2212 by 1659 pixels: 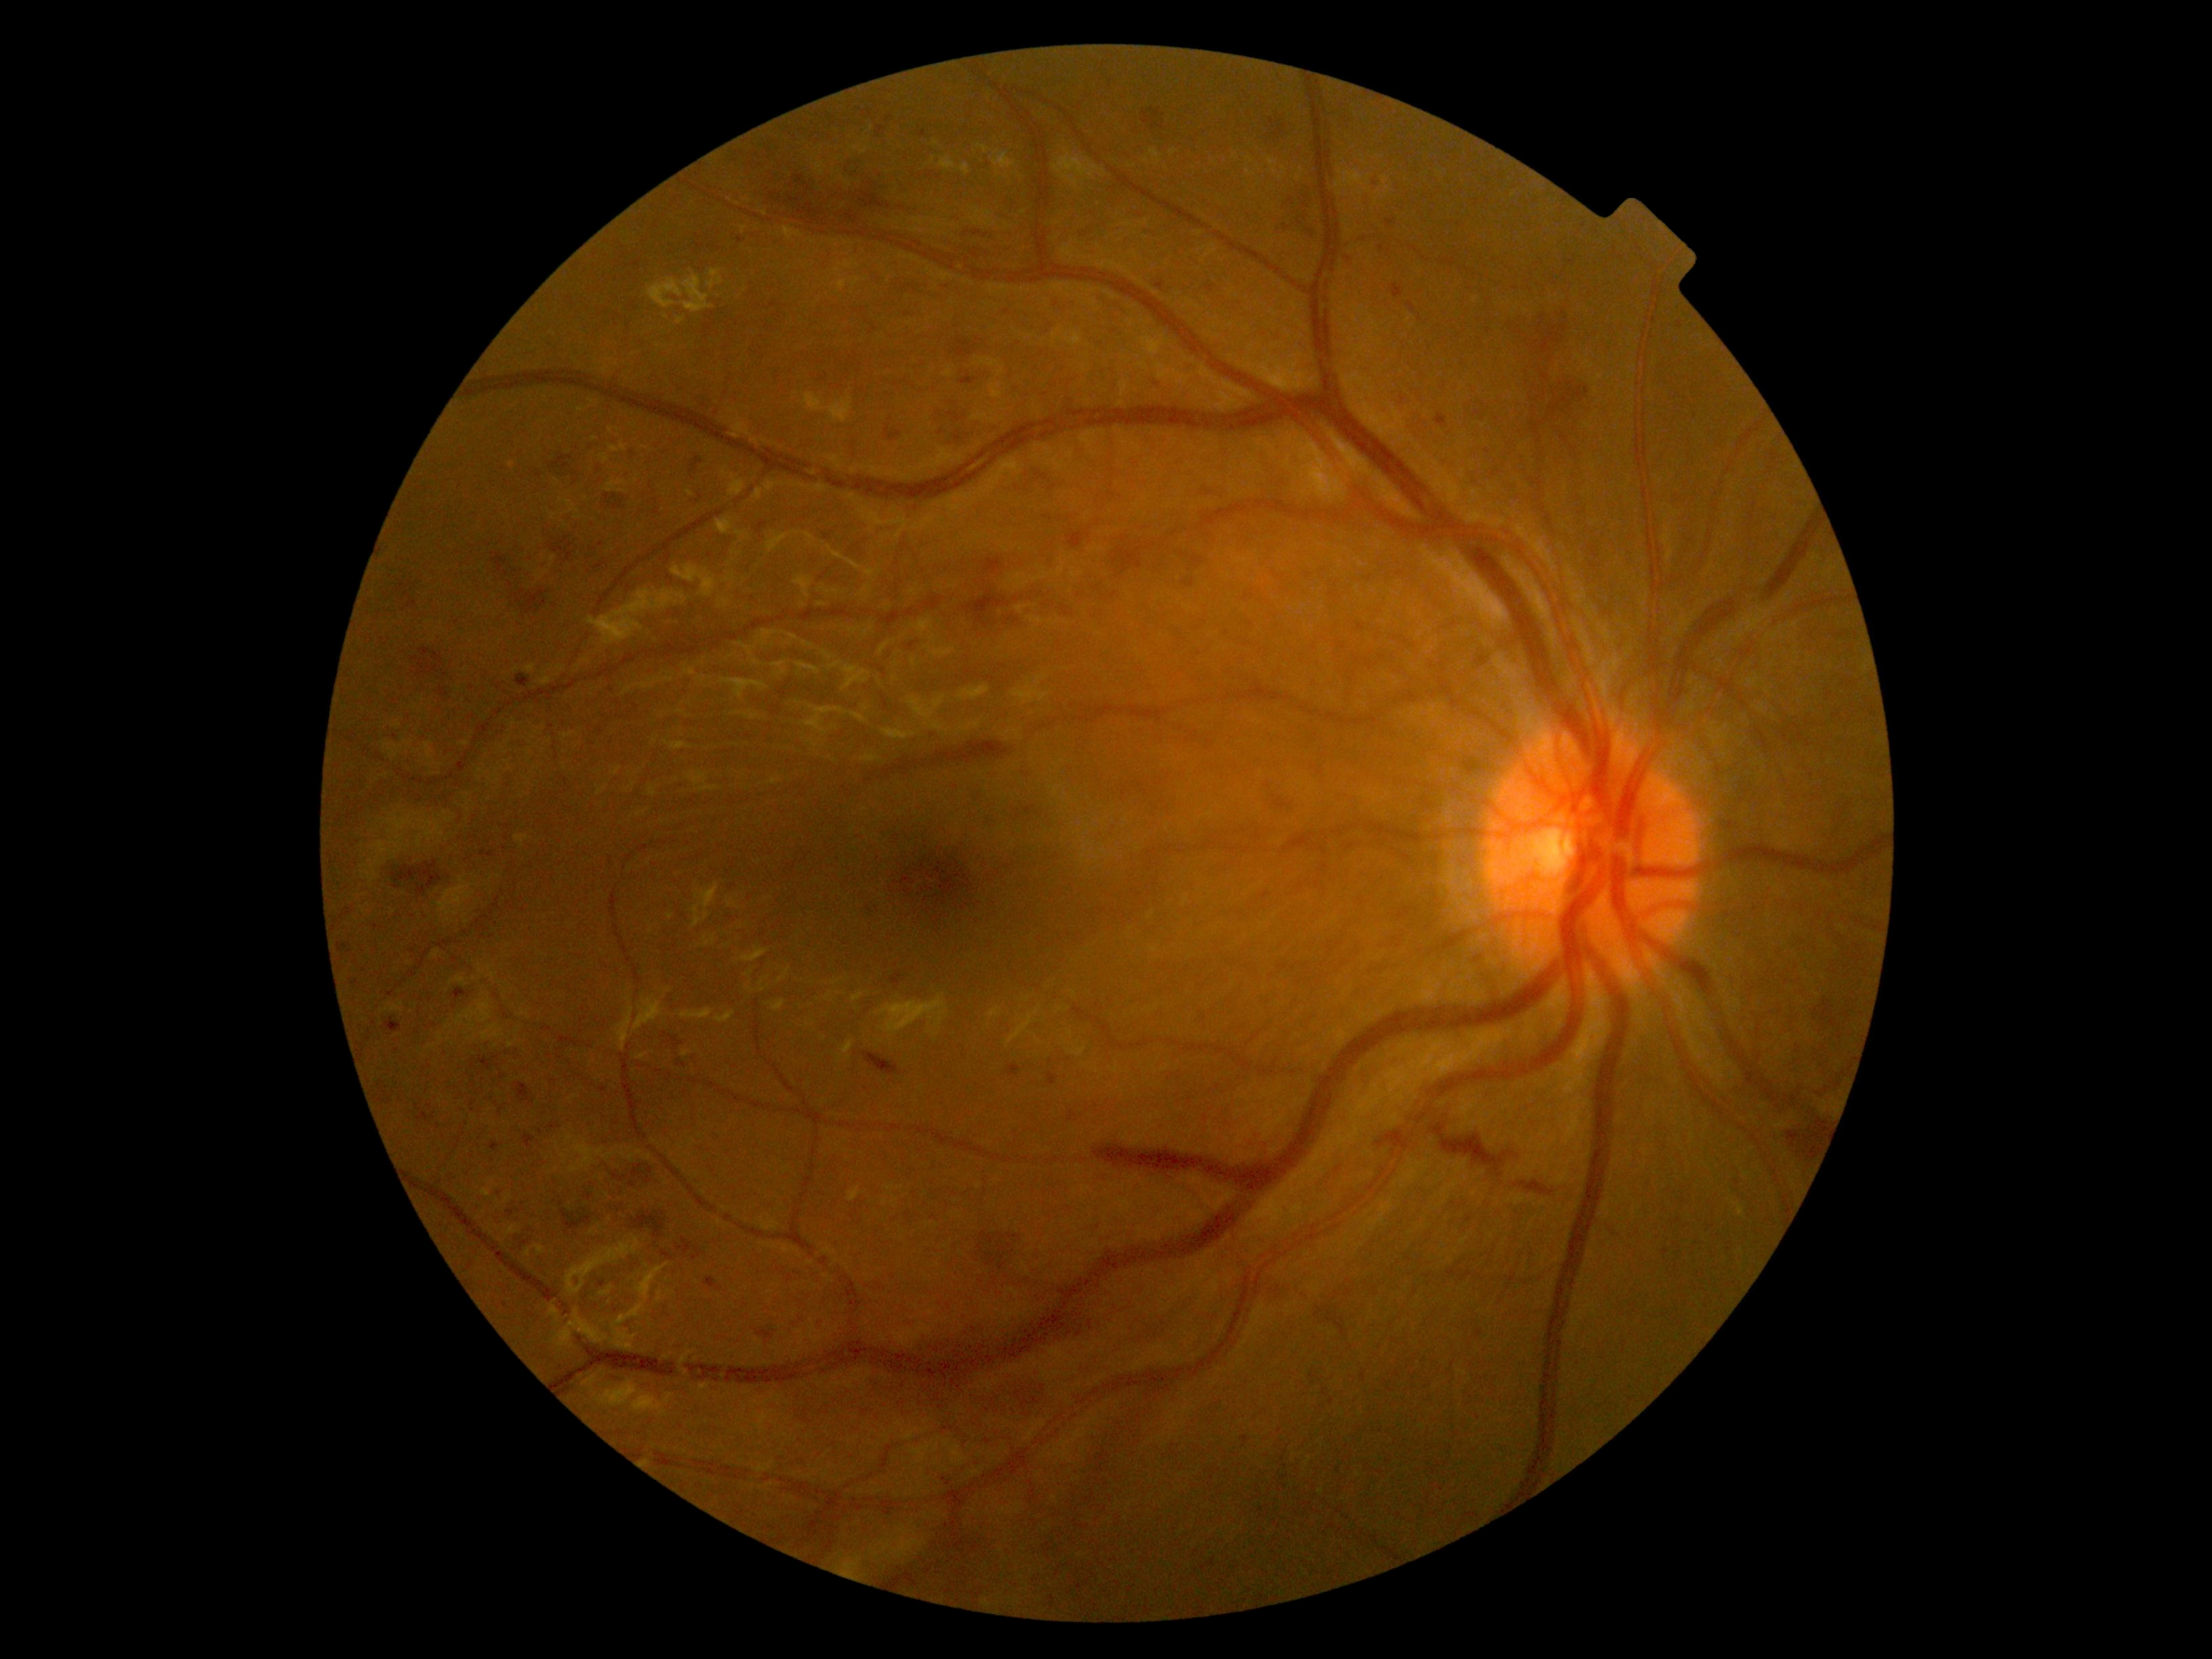
<lesions partial="true">
  <dr_grade>3</dr_grade>
  <he partial="true">986:817:1004:832 | 738:237:743:245 | 631:1212:665:1238 | 613:1173:626:1181 | 662:1250:673:1261 | 1276:190:1321:239 | 415:1104:436:1123 | 970:586:1077:632 | 756:1330:775:1340 | 1515:1181:1554:1195 | 1184:364:1200:376 | 890:972:902:985 | 596:563:608:569</he>
  <he_small_approx>x=553, y=1082 | x=381, y=1101 | x=632, y=453 | x=910, y=647 | x=1231, y=1209 | x=890, y=118</he_small_approx>
</lesions>